Optic nerve head photograph · captured with pupil dilation: 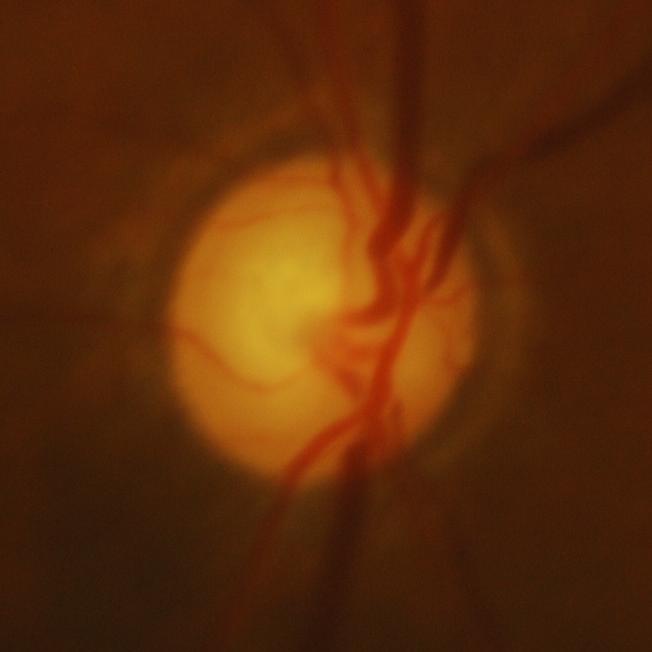 Glaucoma is present. Diagnosis: glaucomatous damage to the optic nerve.